45° FOV, acquired with a NIDEK AFC-230, CFP, nonmydriatic fundus photograph, 848 x 848 pixels, diabetic retinopathy graded by the modified Davis classification.
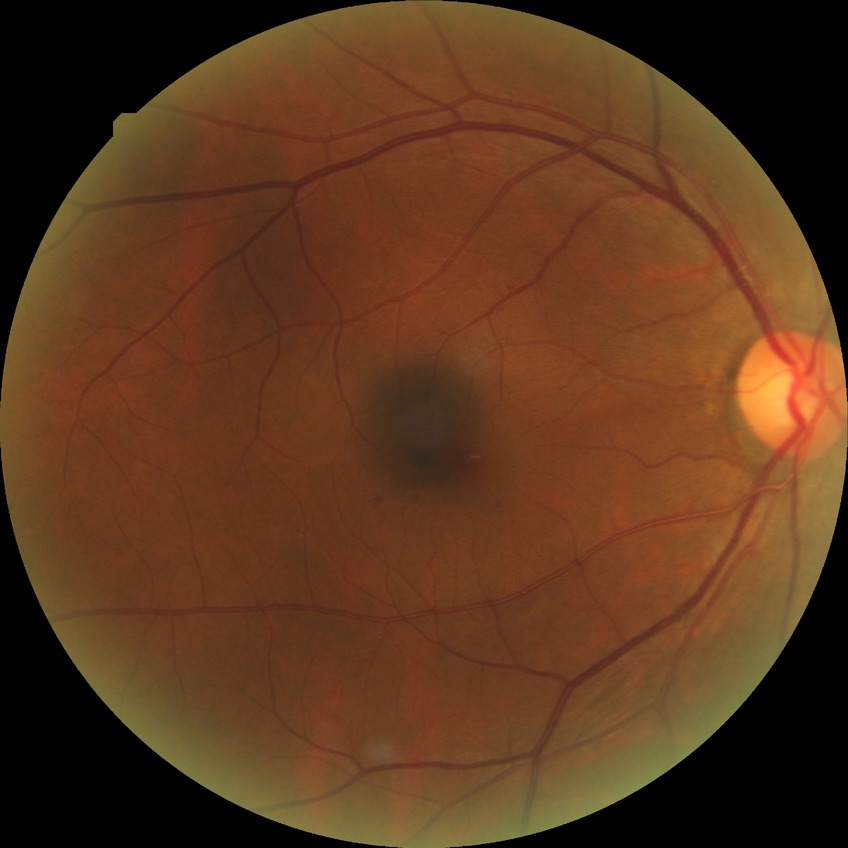
Diabetic retinopathy (DR): simple diabetic retinopathy (SDR).